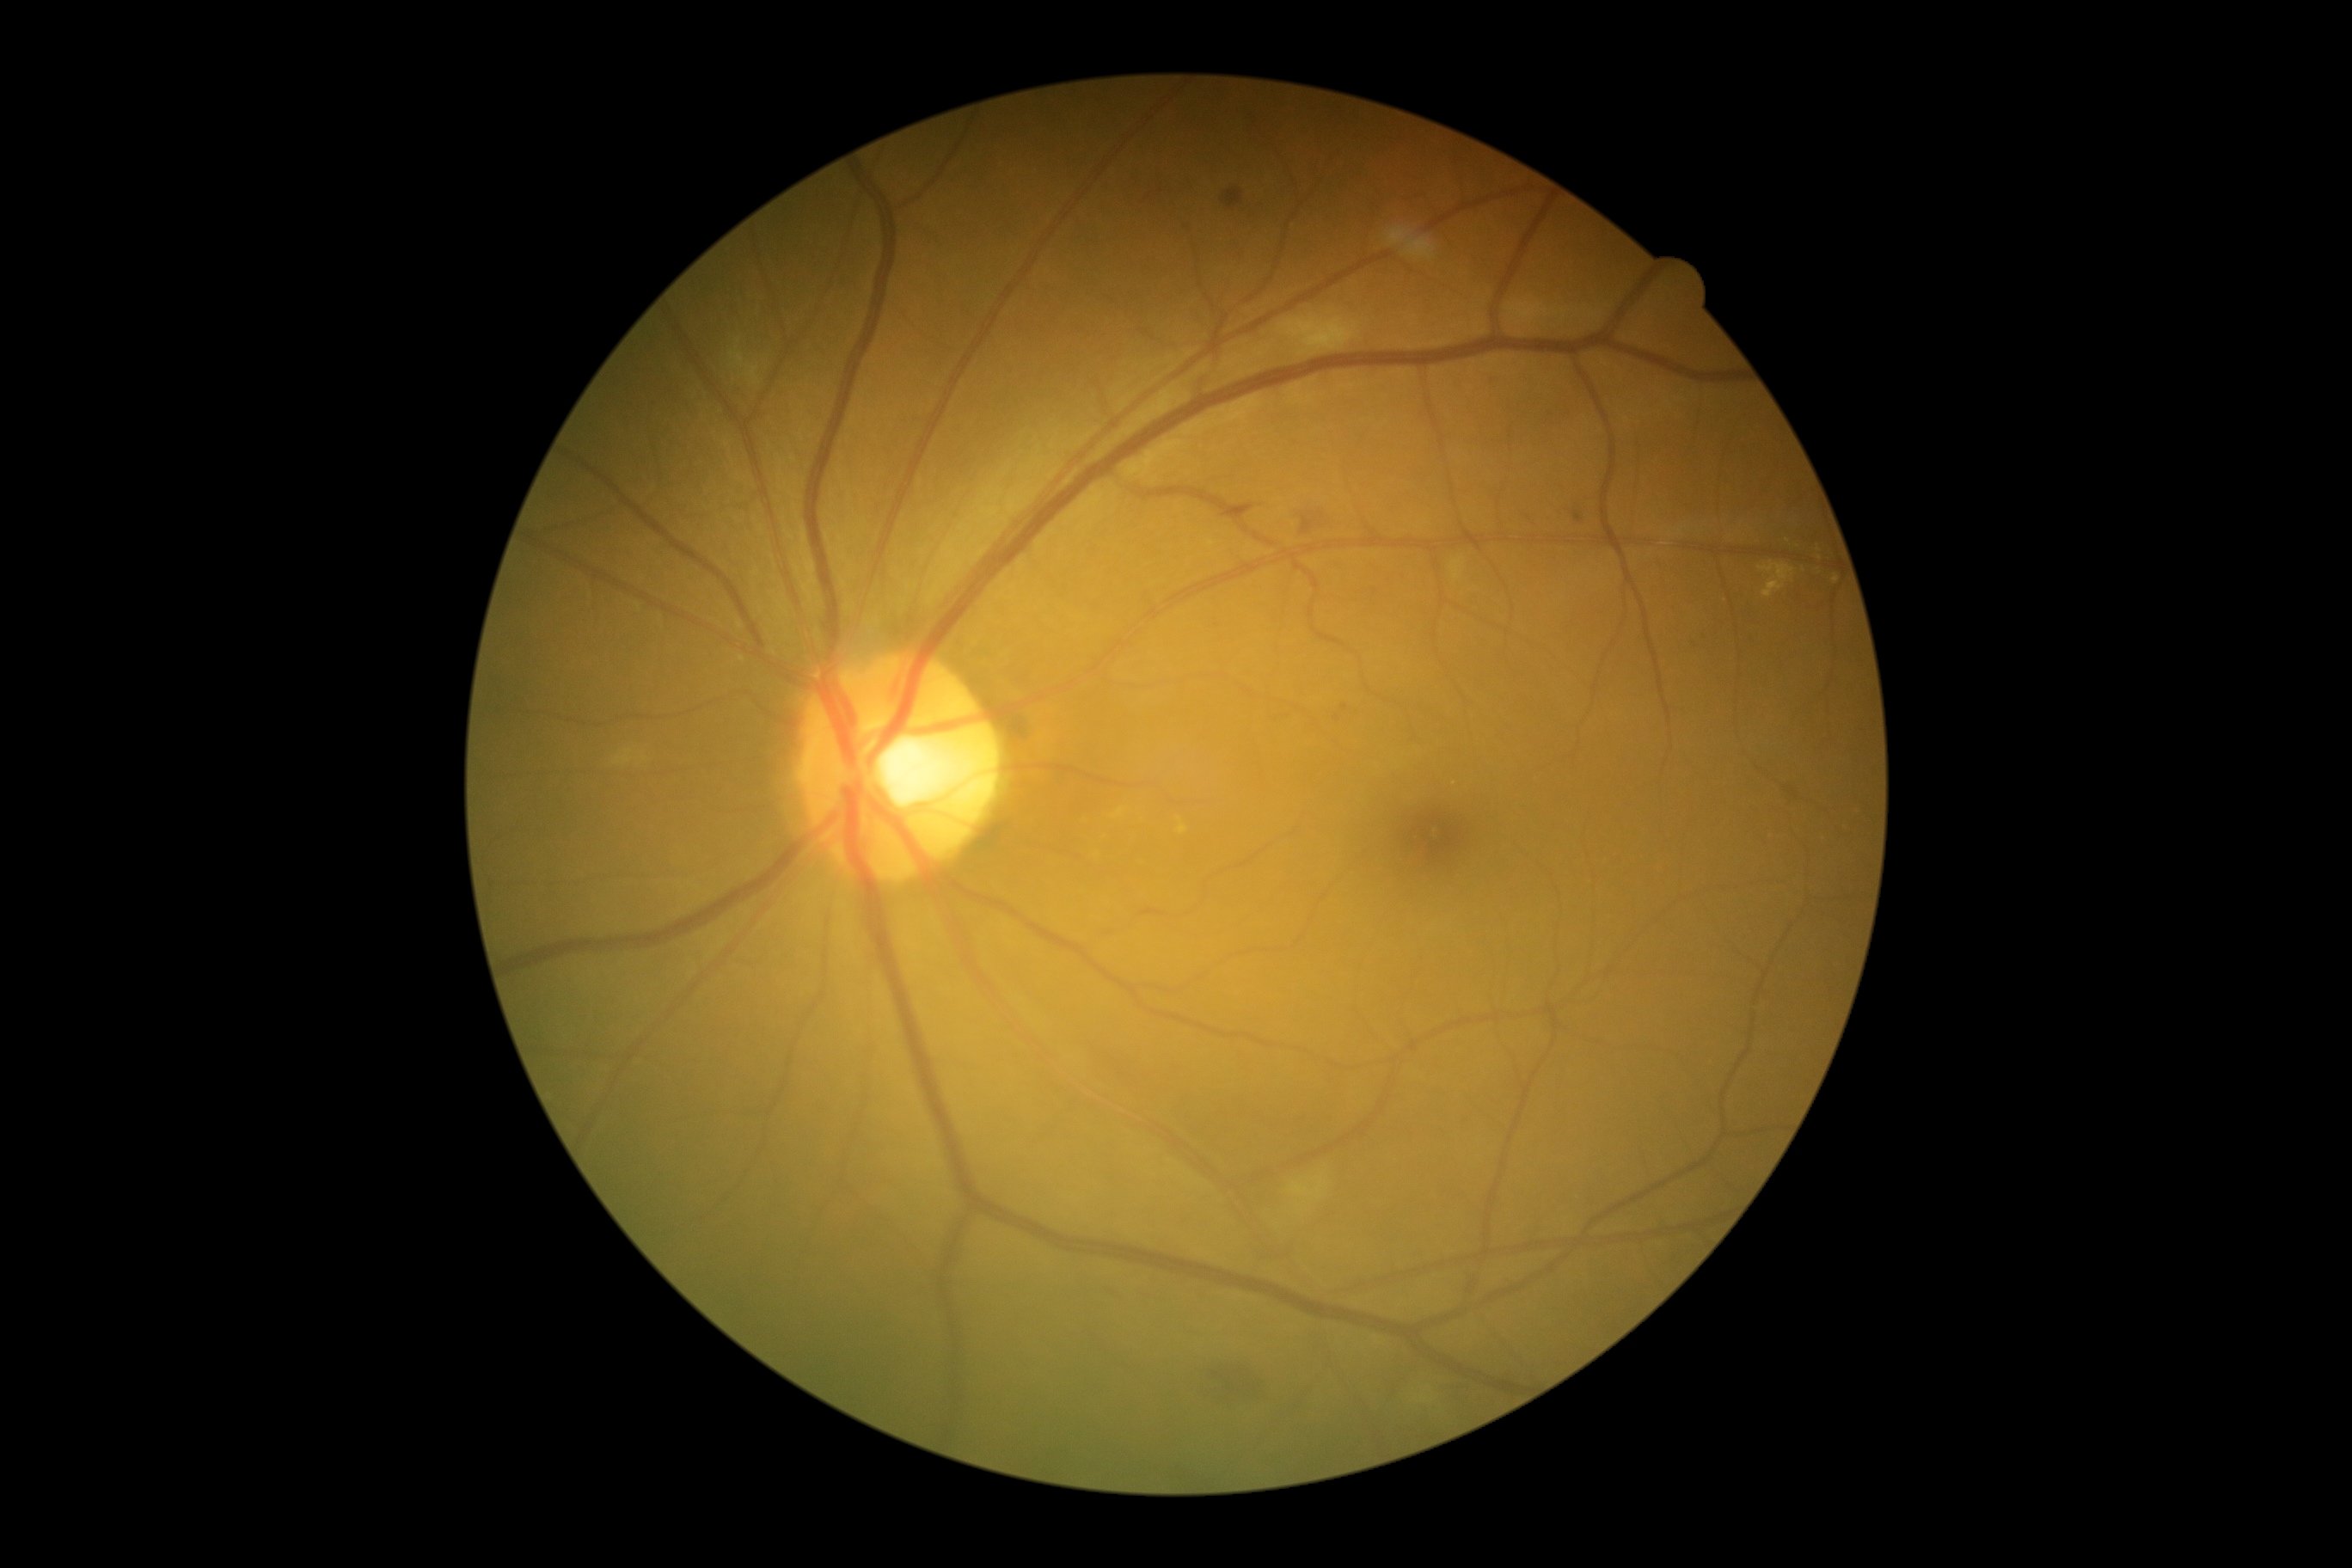 diabetic retinopathy = moderate non-proliferative diabetic retinopathy (grade 2)